Posterior pole photograph; NIDEK AFC-230; no pharmacologic dilation; 848 x 848 pixels; 45° field of view
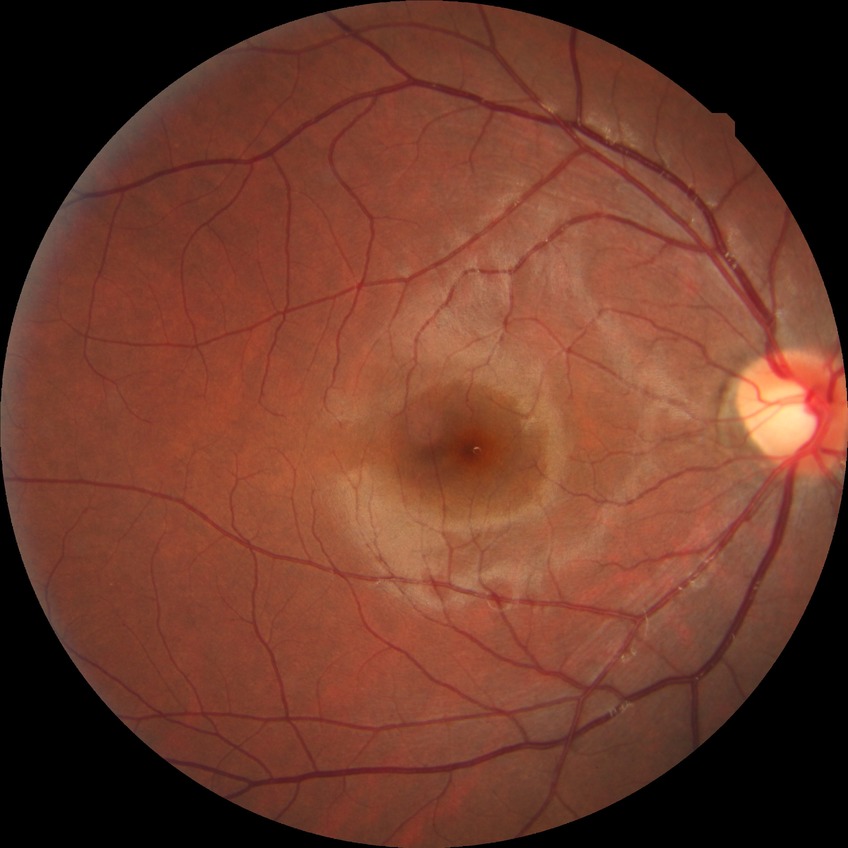

Diabetic retinopathy (DR) is NDR (no diabetic retinopathy).